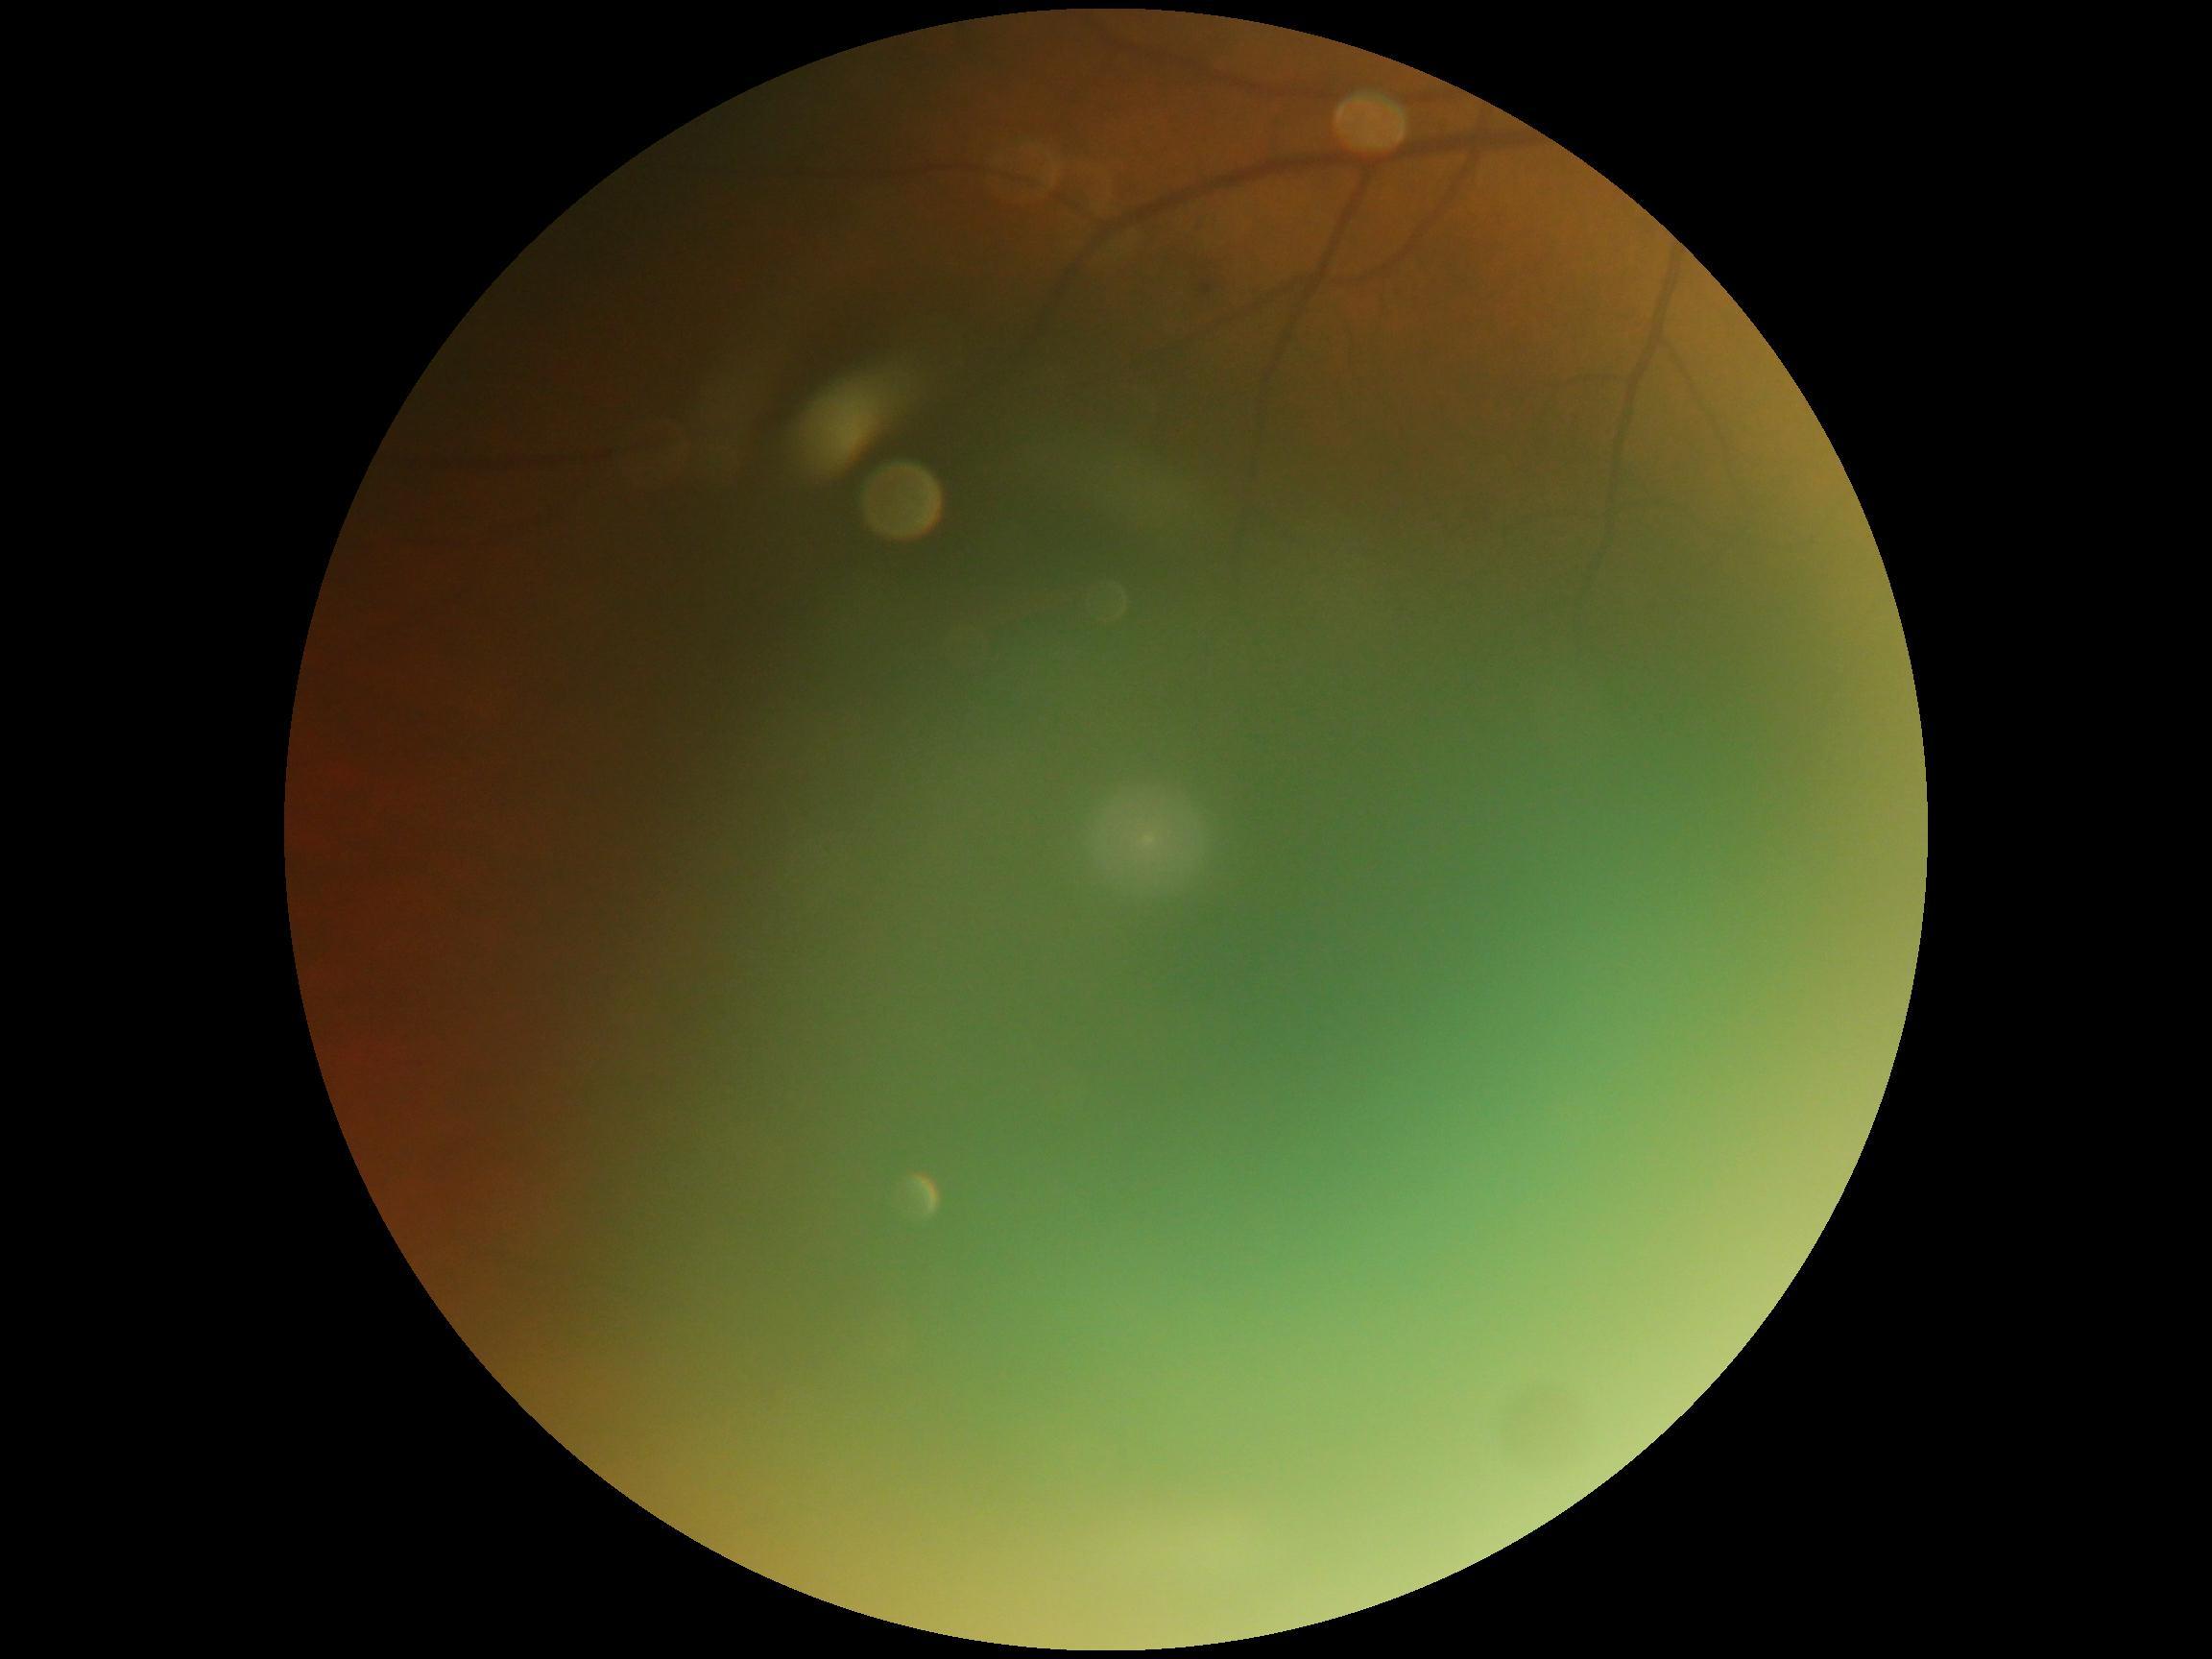 Ungradable image — DR severity cannot be determined. DR severity: ungradable due to poor image quality.